Wide-field fundus photograph of an infant:
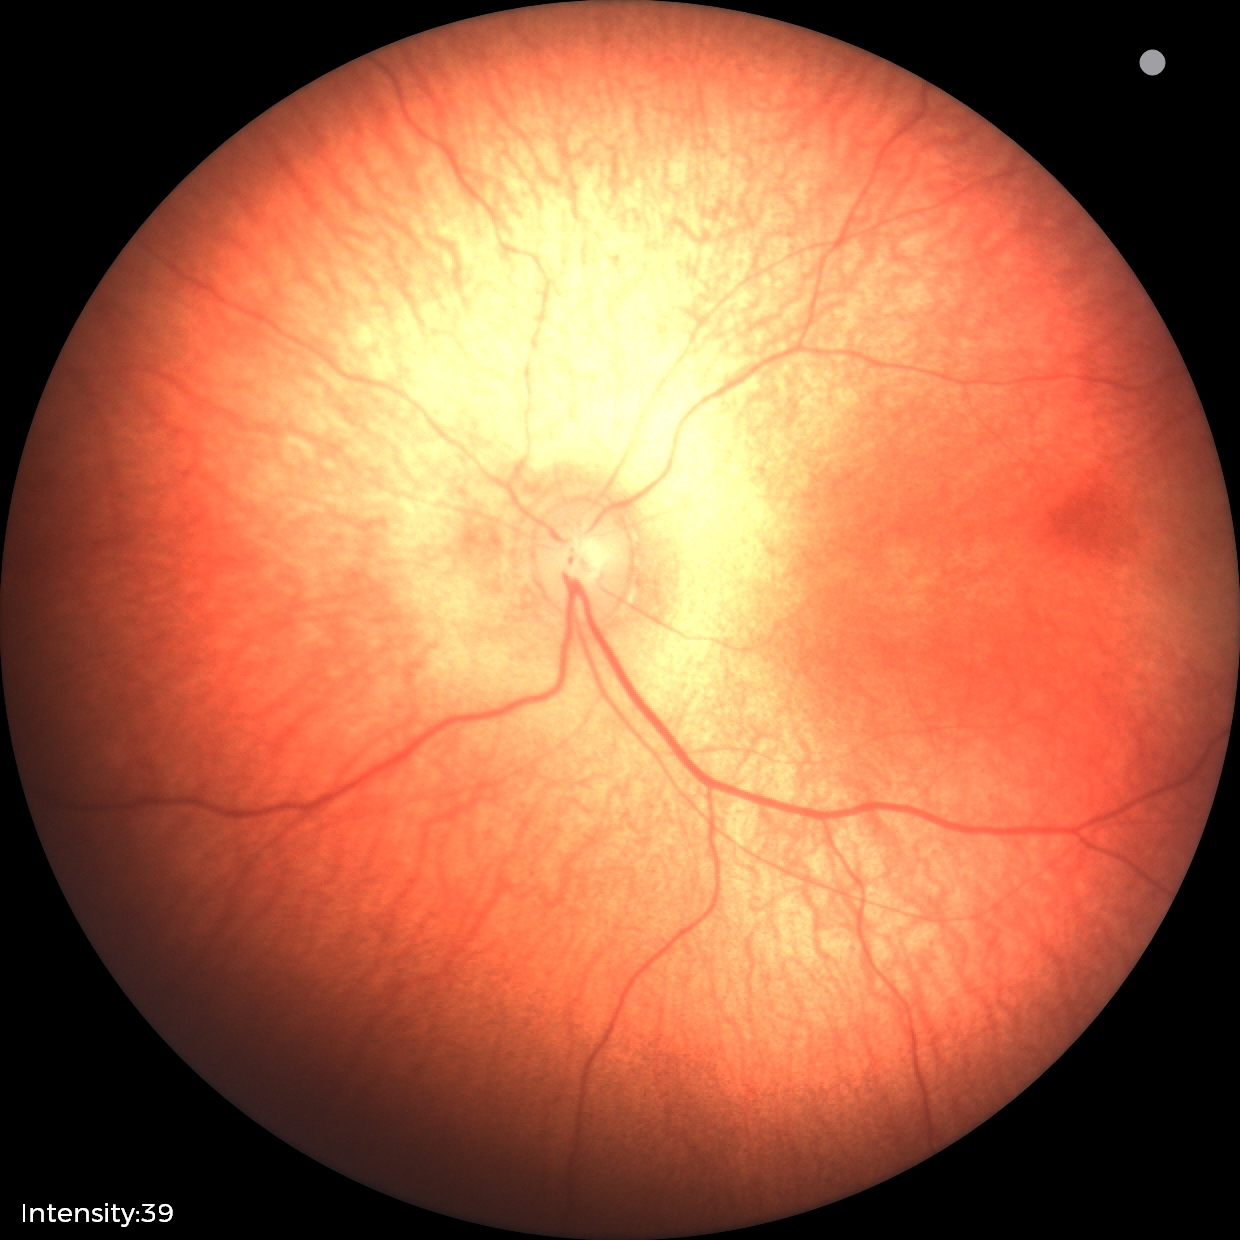
Normal screening examination.